Captured with the Phoenix ICON (100° field of view) · Phoenix ICON wide-field infant fundus image.
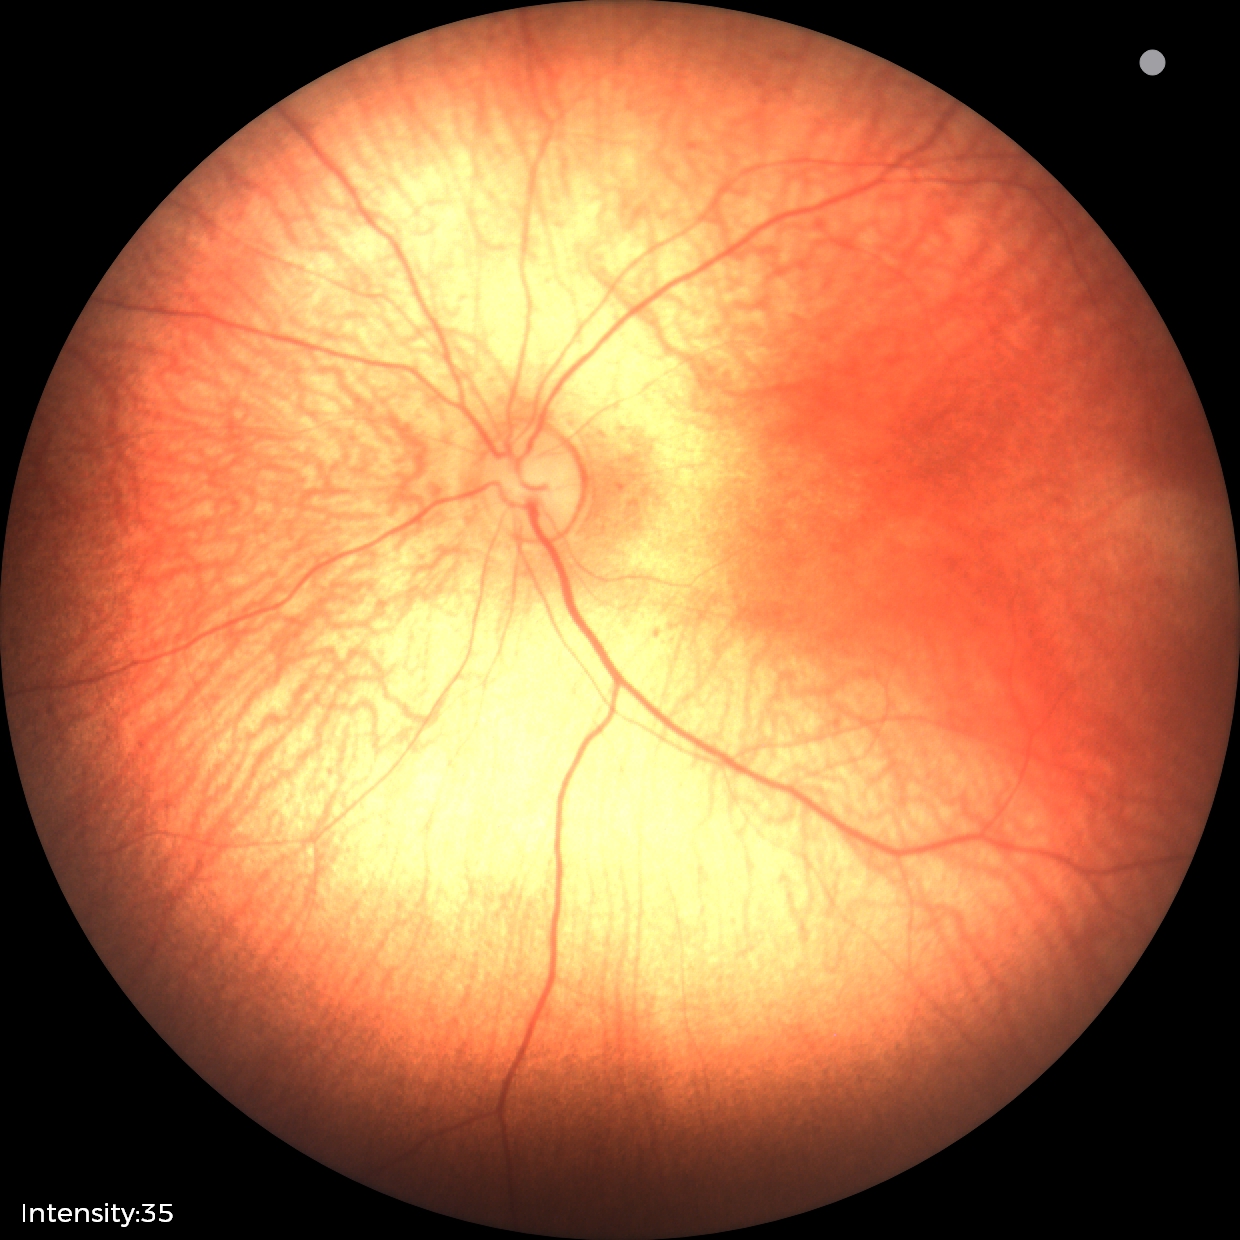 Assessment: normal retinal appearance.